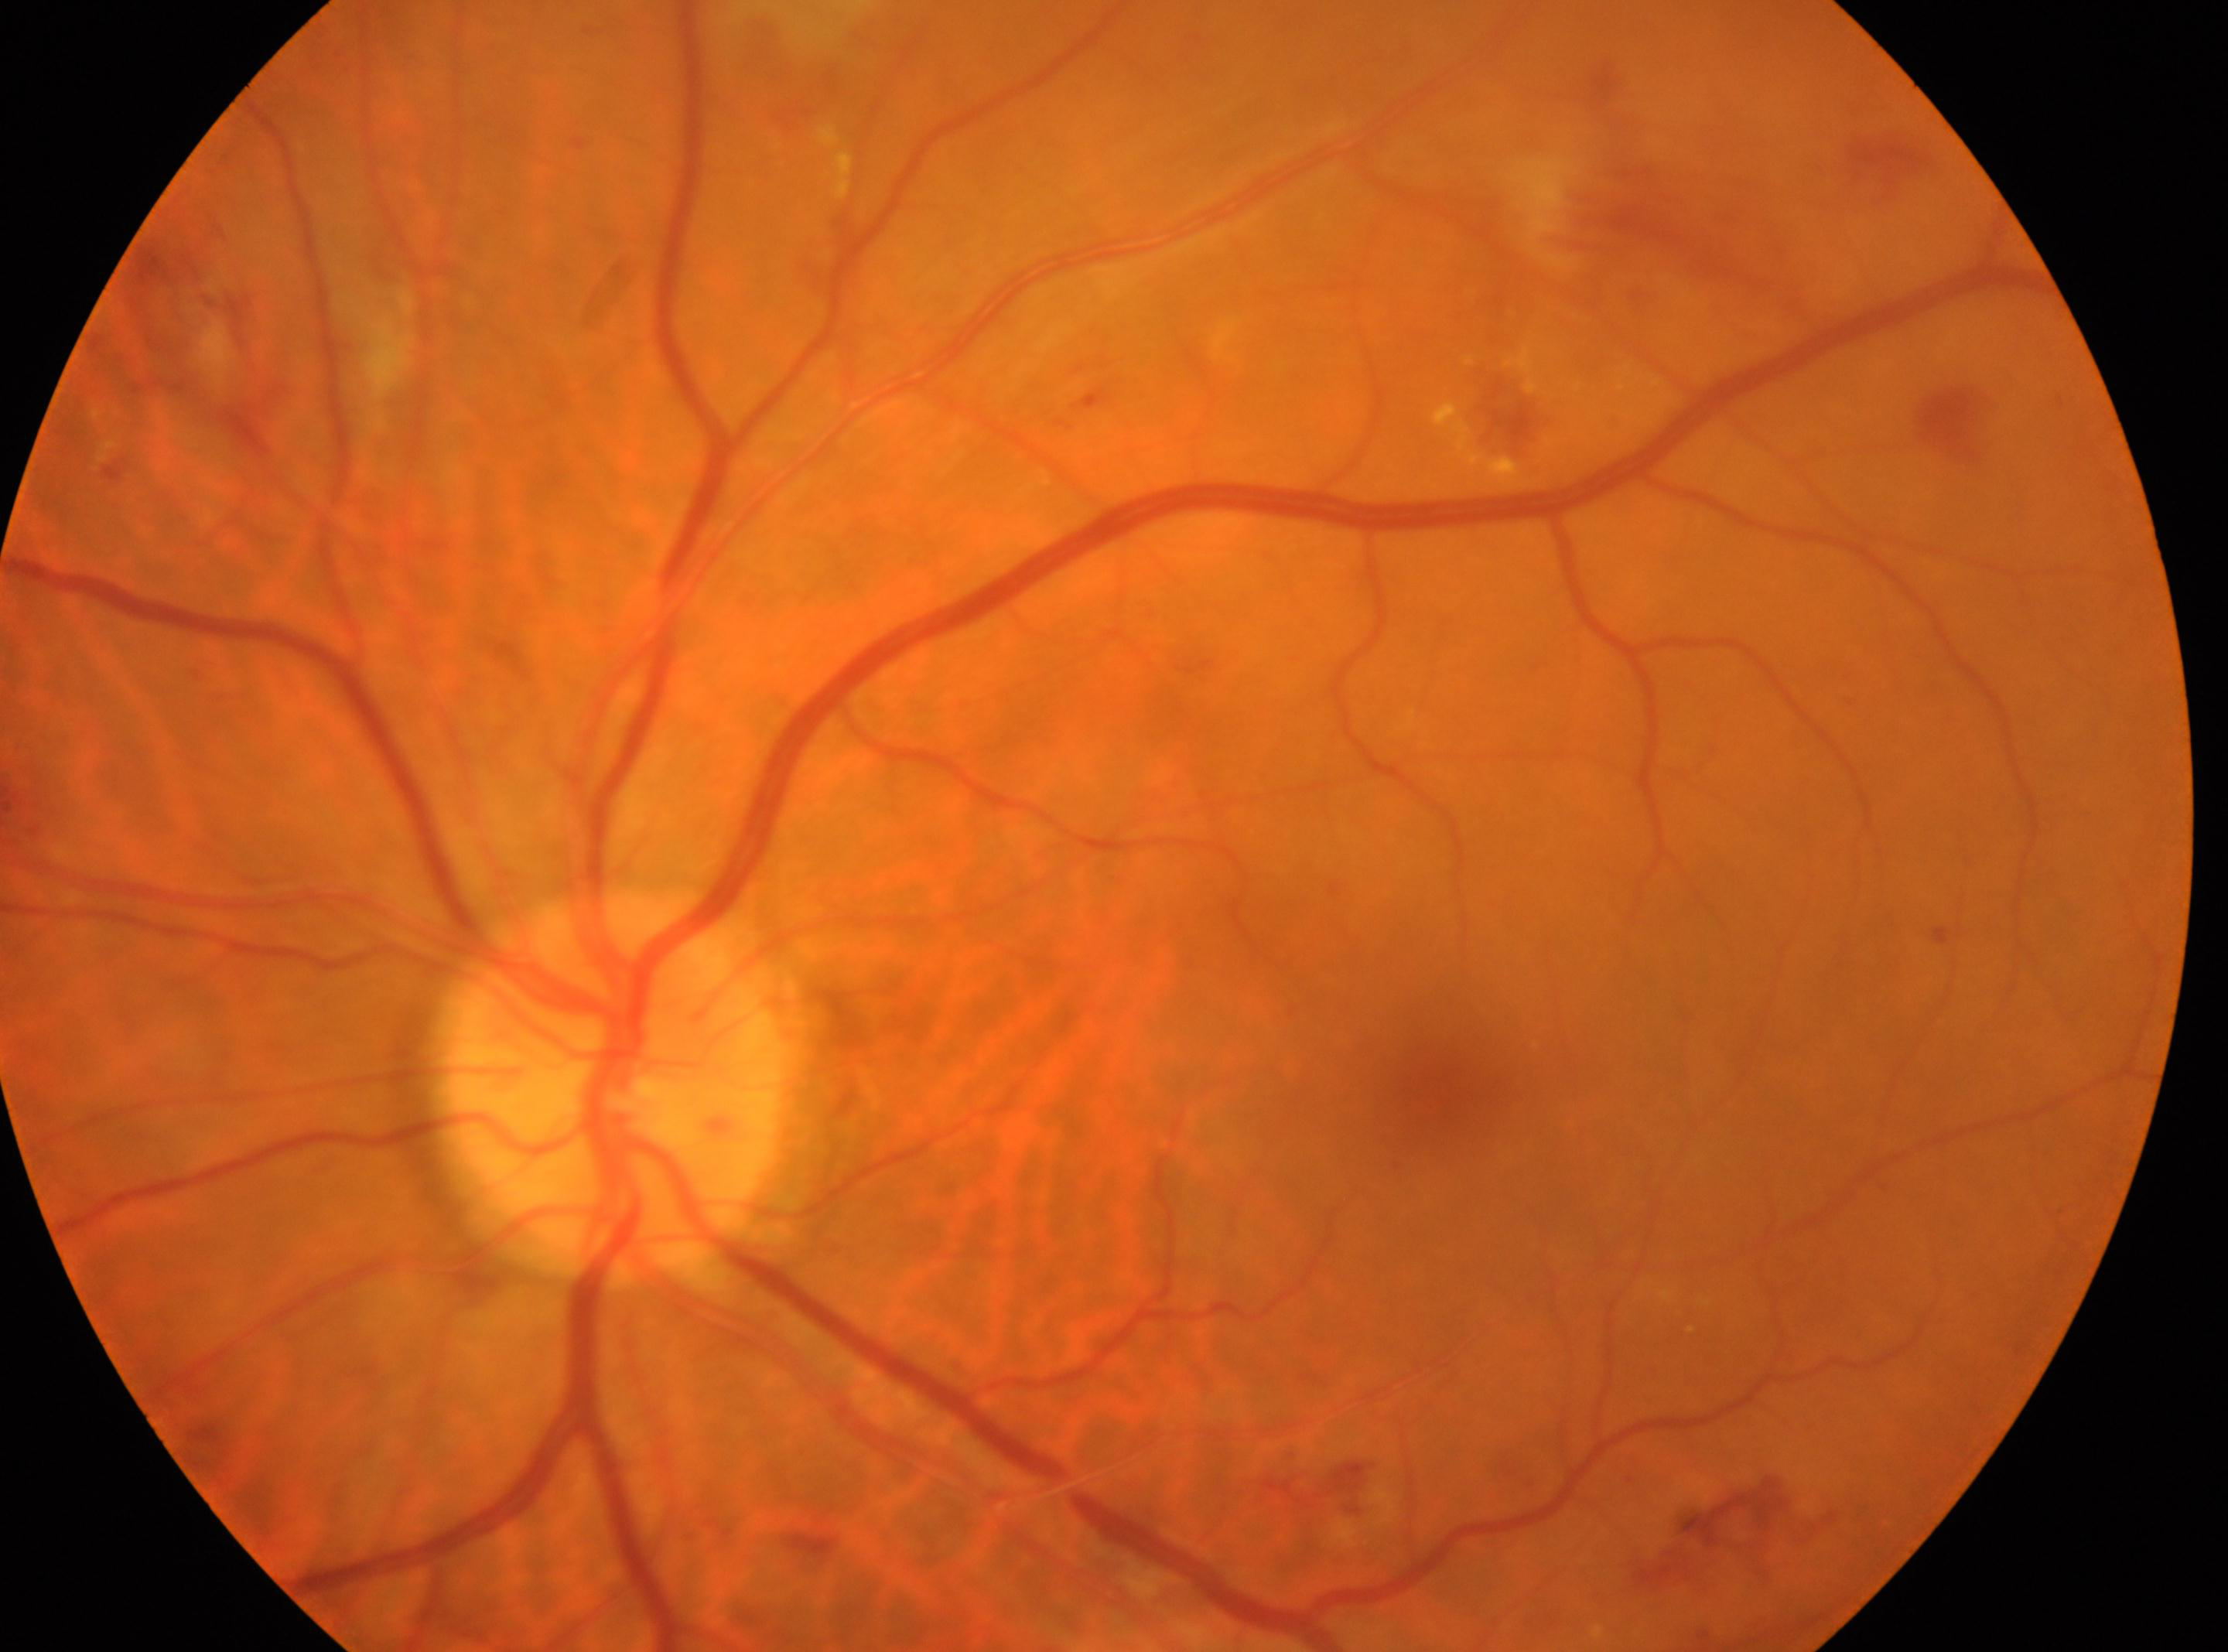 DR stage = 2/4
optic disk = 613, 1078
macular center = 1434, 1095
laterality = left eye